Retinal fundus photograph, image size 512x512:
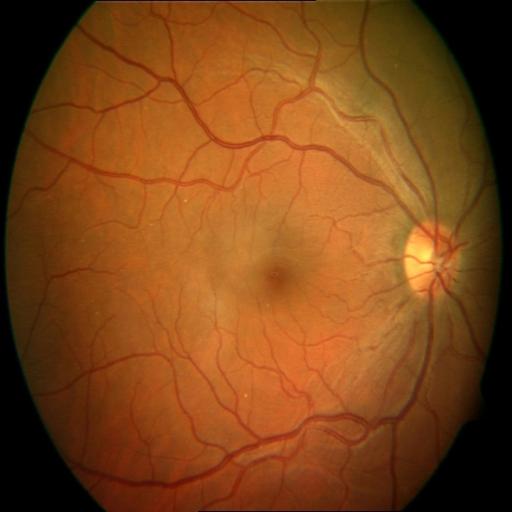
Showing cystoid macular edema.